Color fundus photograph. 45° FOV. 2048x1536px — 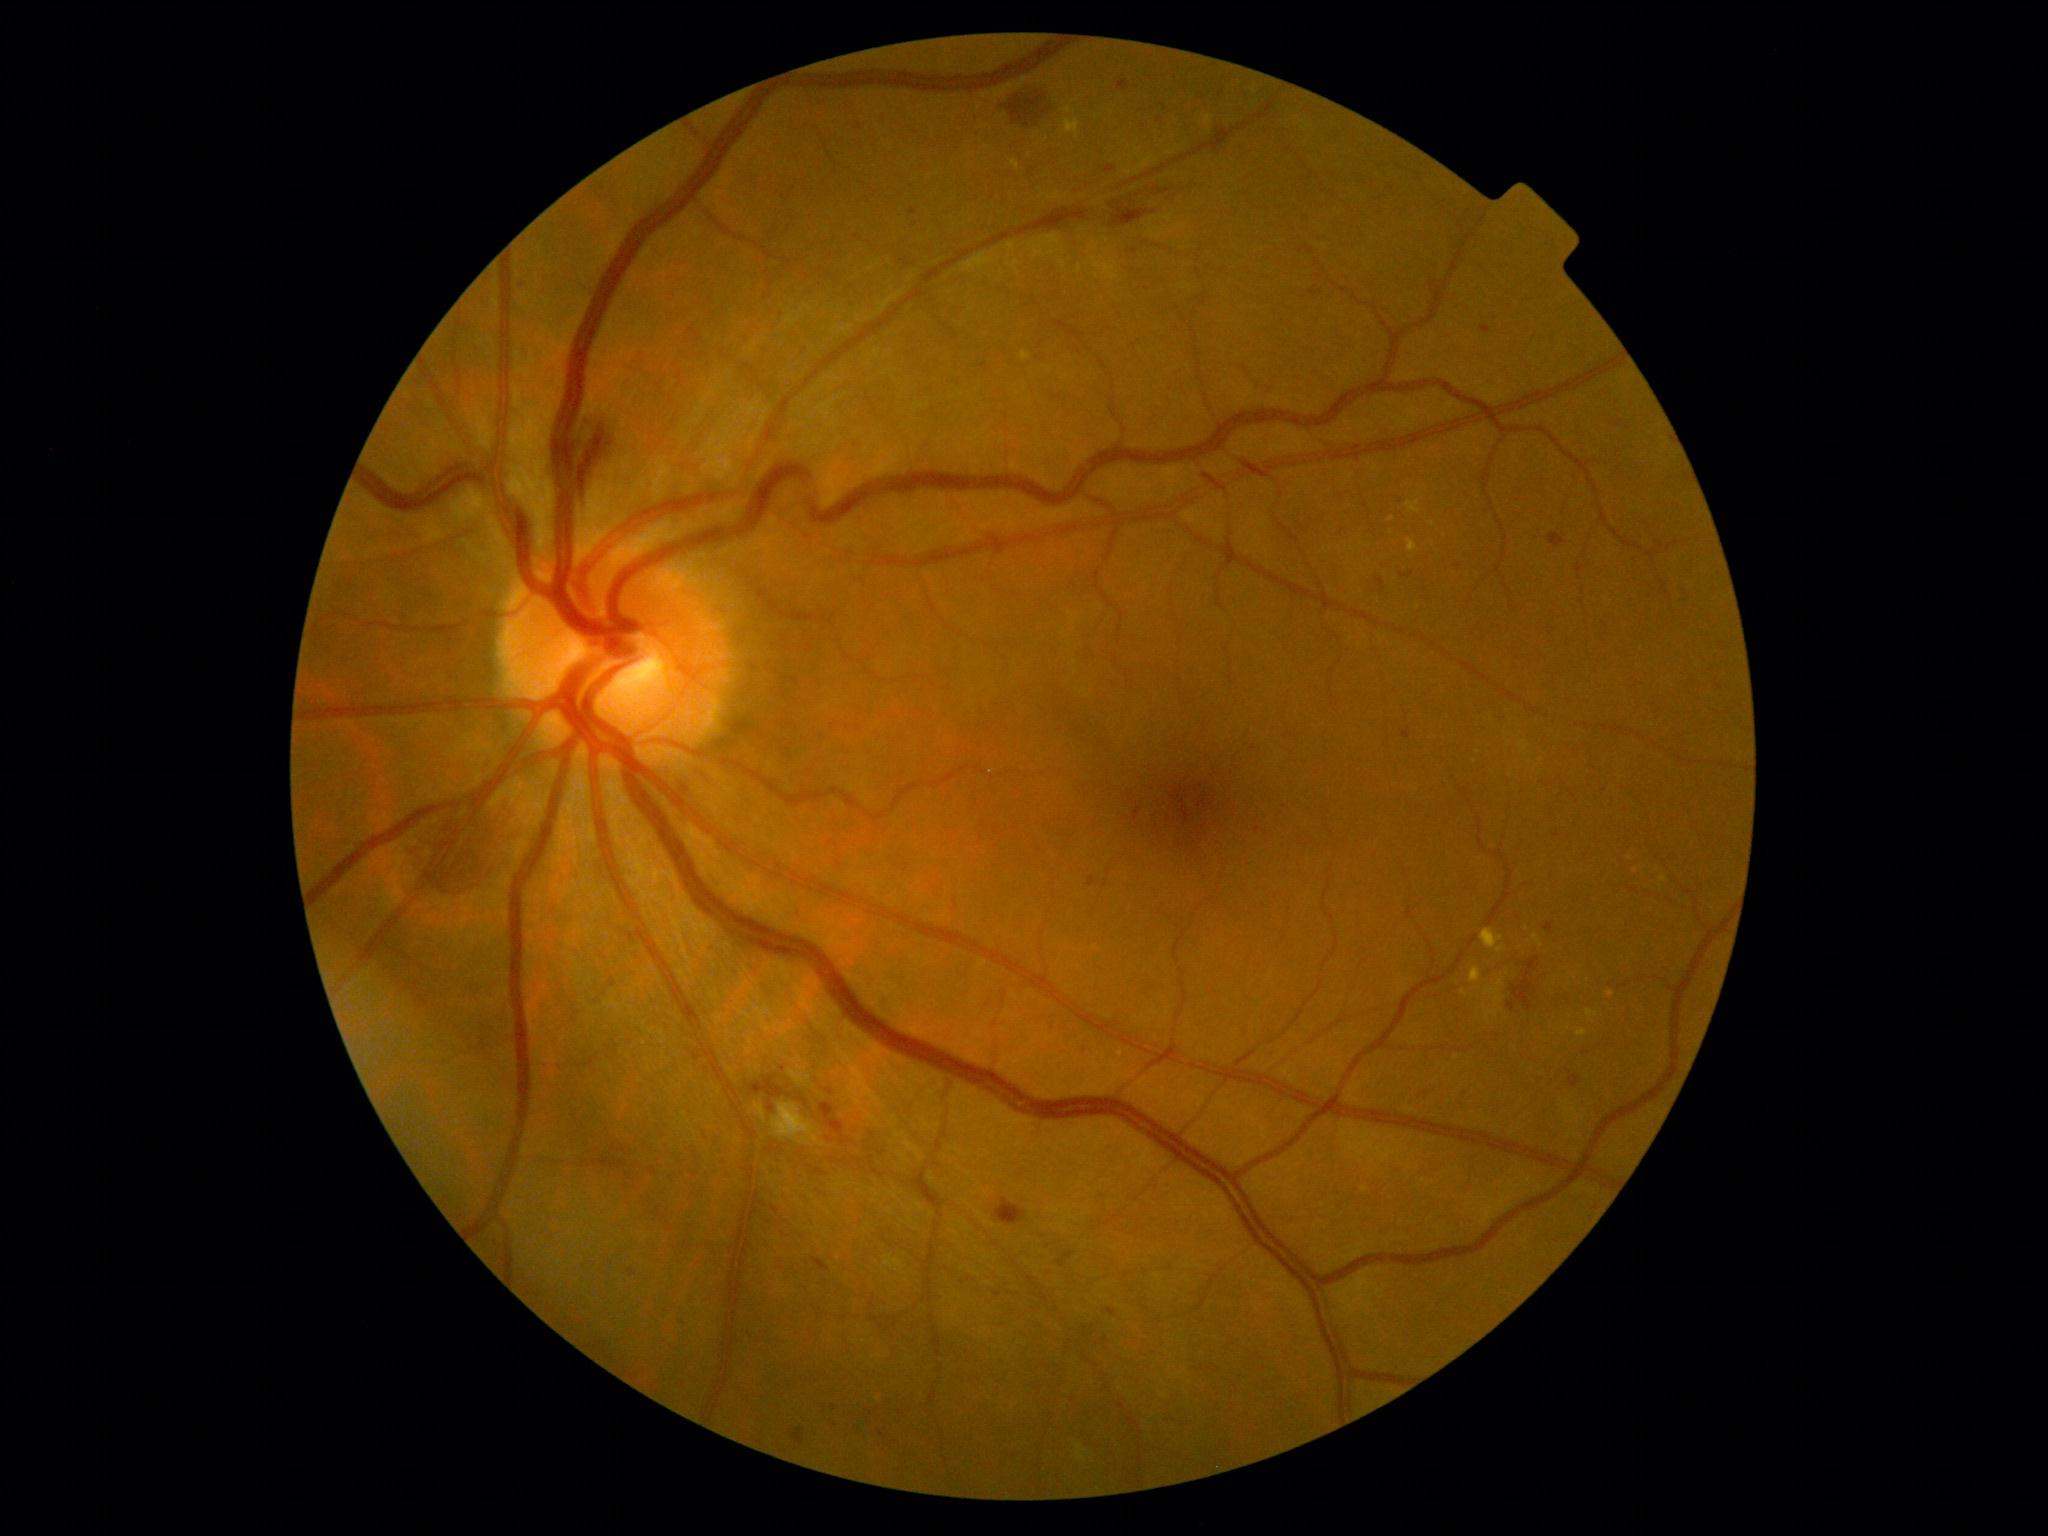 DR stage: grade 2 (moderate NPDR).